Acquired with a Nidek AFC-330 · 240x240px:
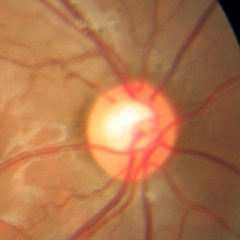

Fundus image with findings of no glaucomatous changes.